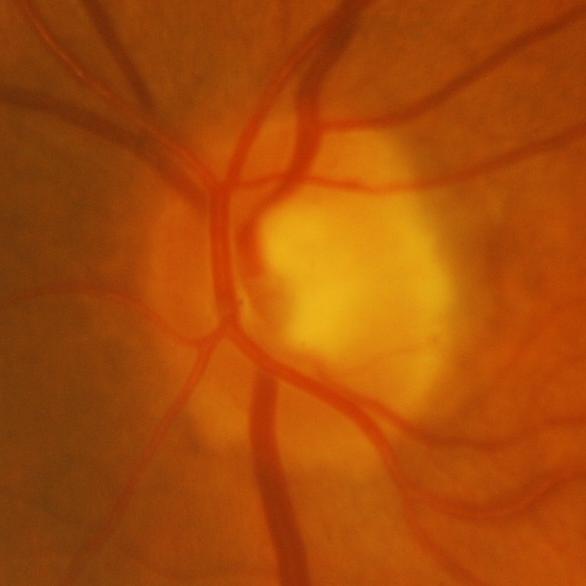

Impression = glaucomatous damage to the optic nerve.